Fundus photo · captured on a Remidio Fundus on Phone · image size 1659x2212 — 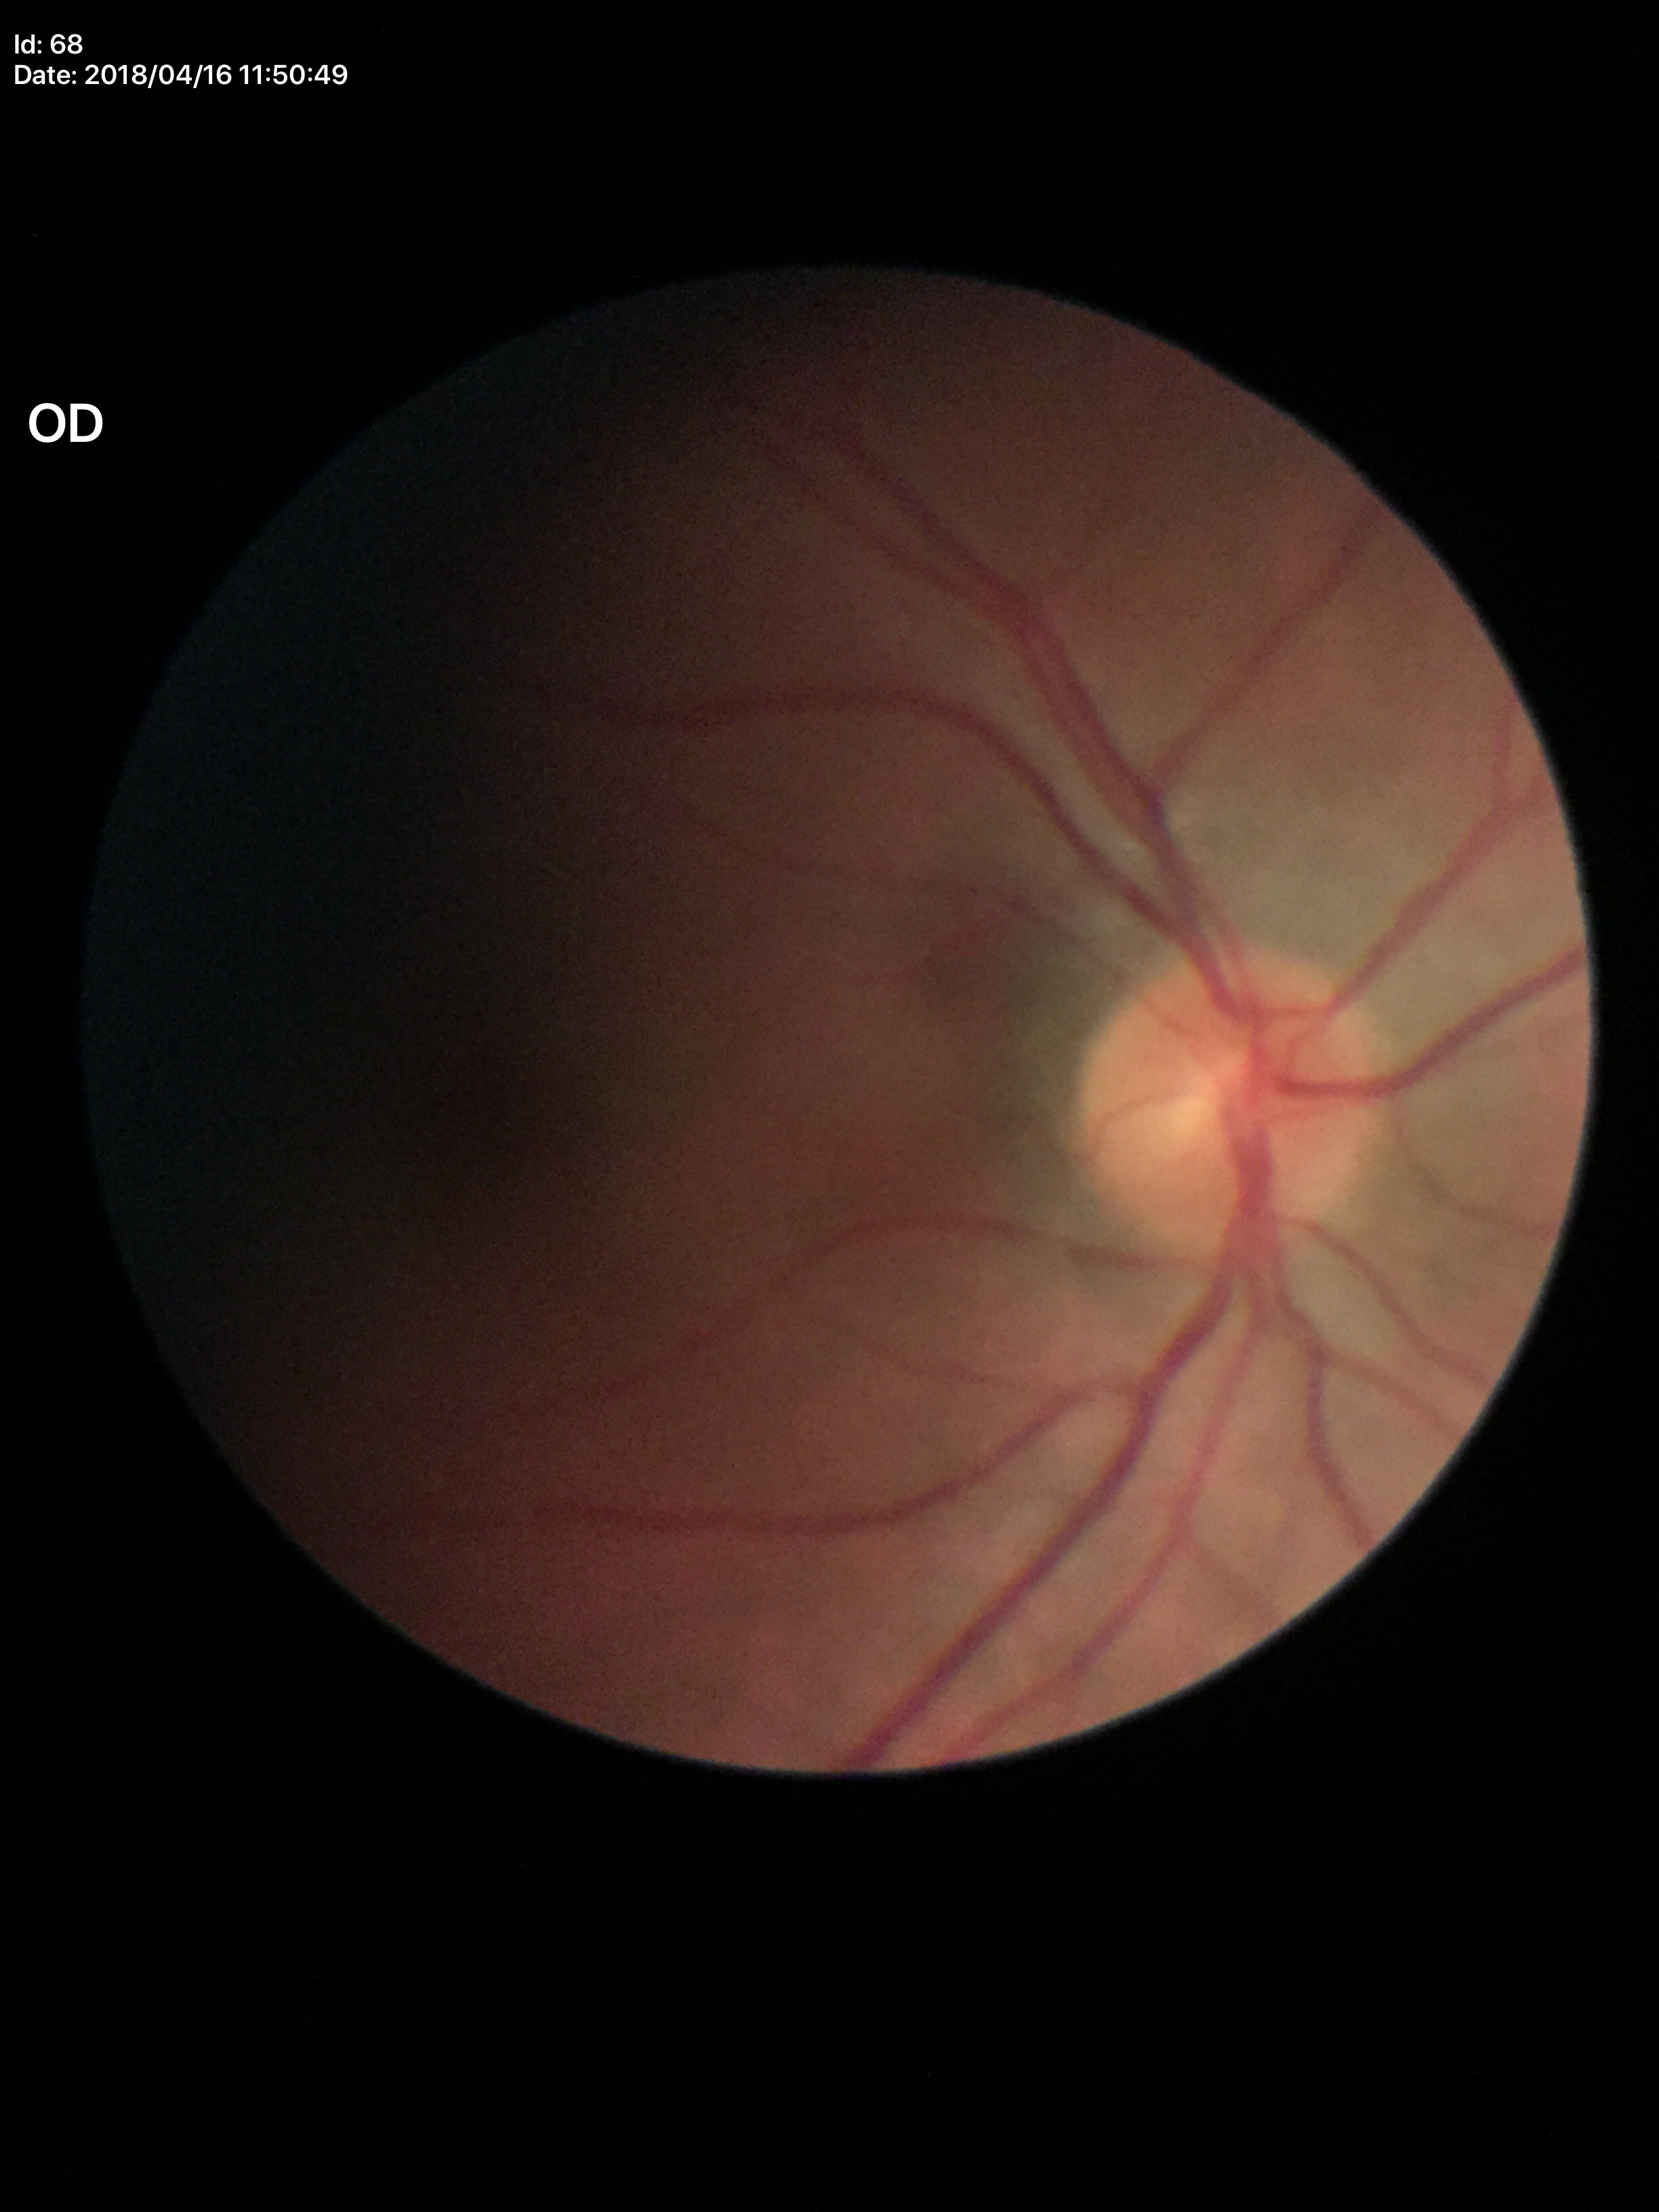 Optic disc analysis:
- Glaucoma evaluation · not suspect
- VCDR · 0.45
- HCDR · 0.43
- ACDR · 0.19